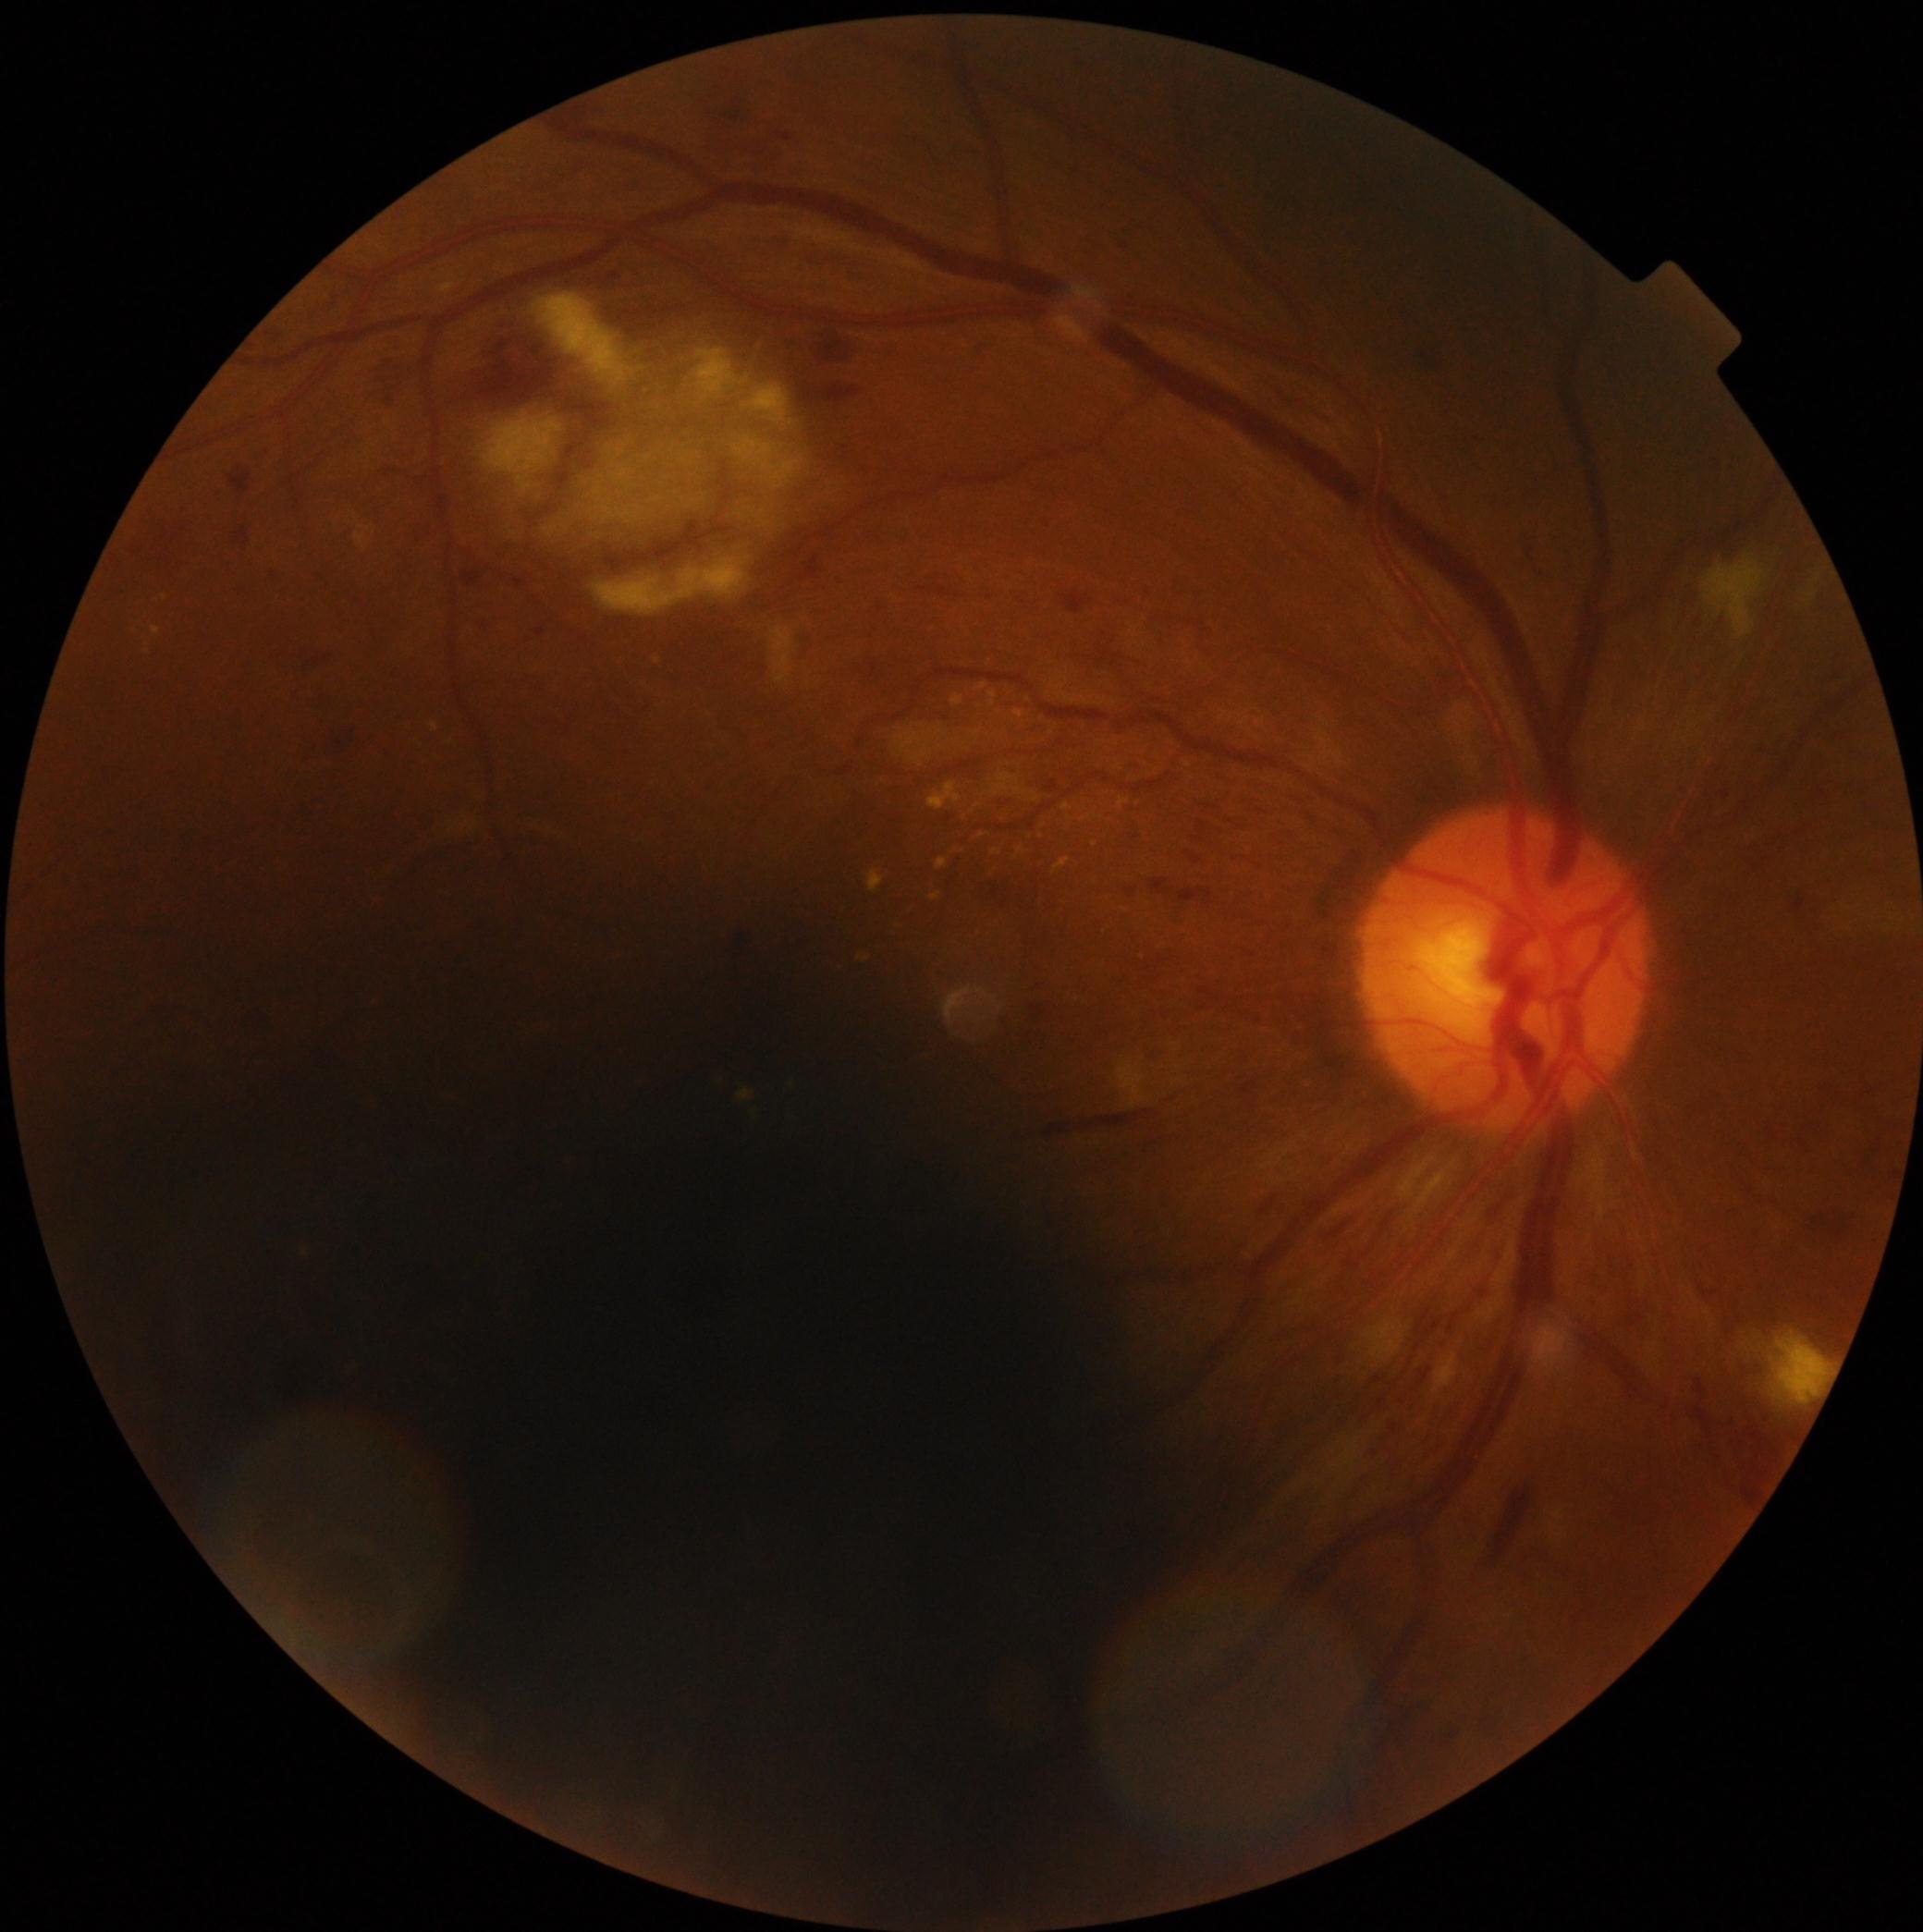
DR class: non-proliferative diabetic retinopathy, DR stage: grade 3 (severe NPDR).